1932x1916. 45° field of view. Retinal fundus photograph: 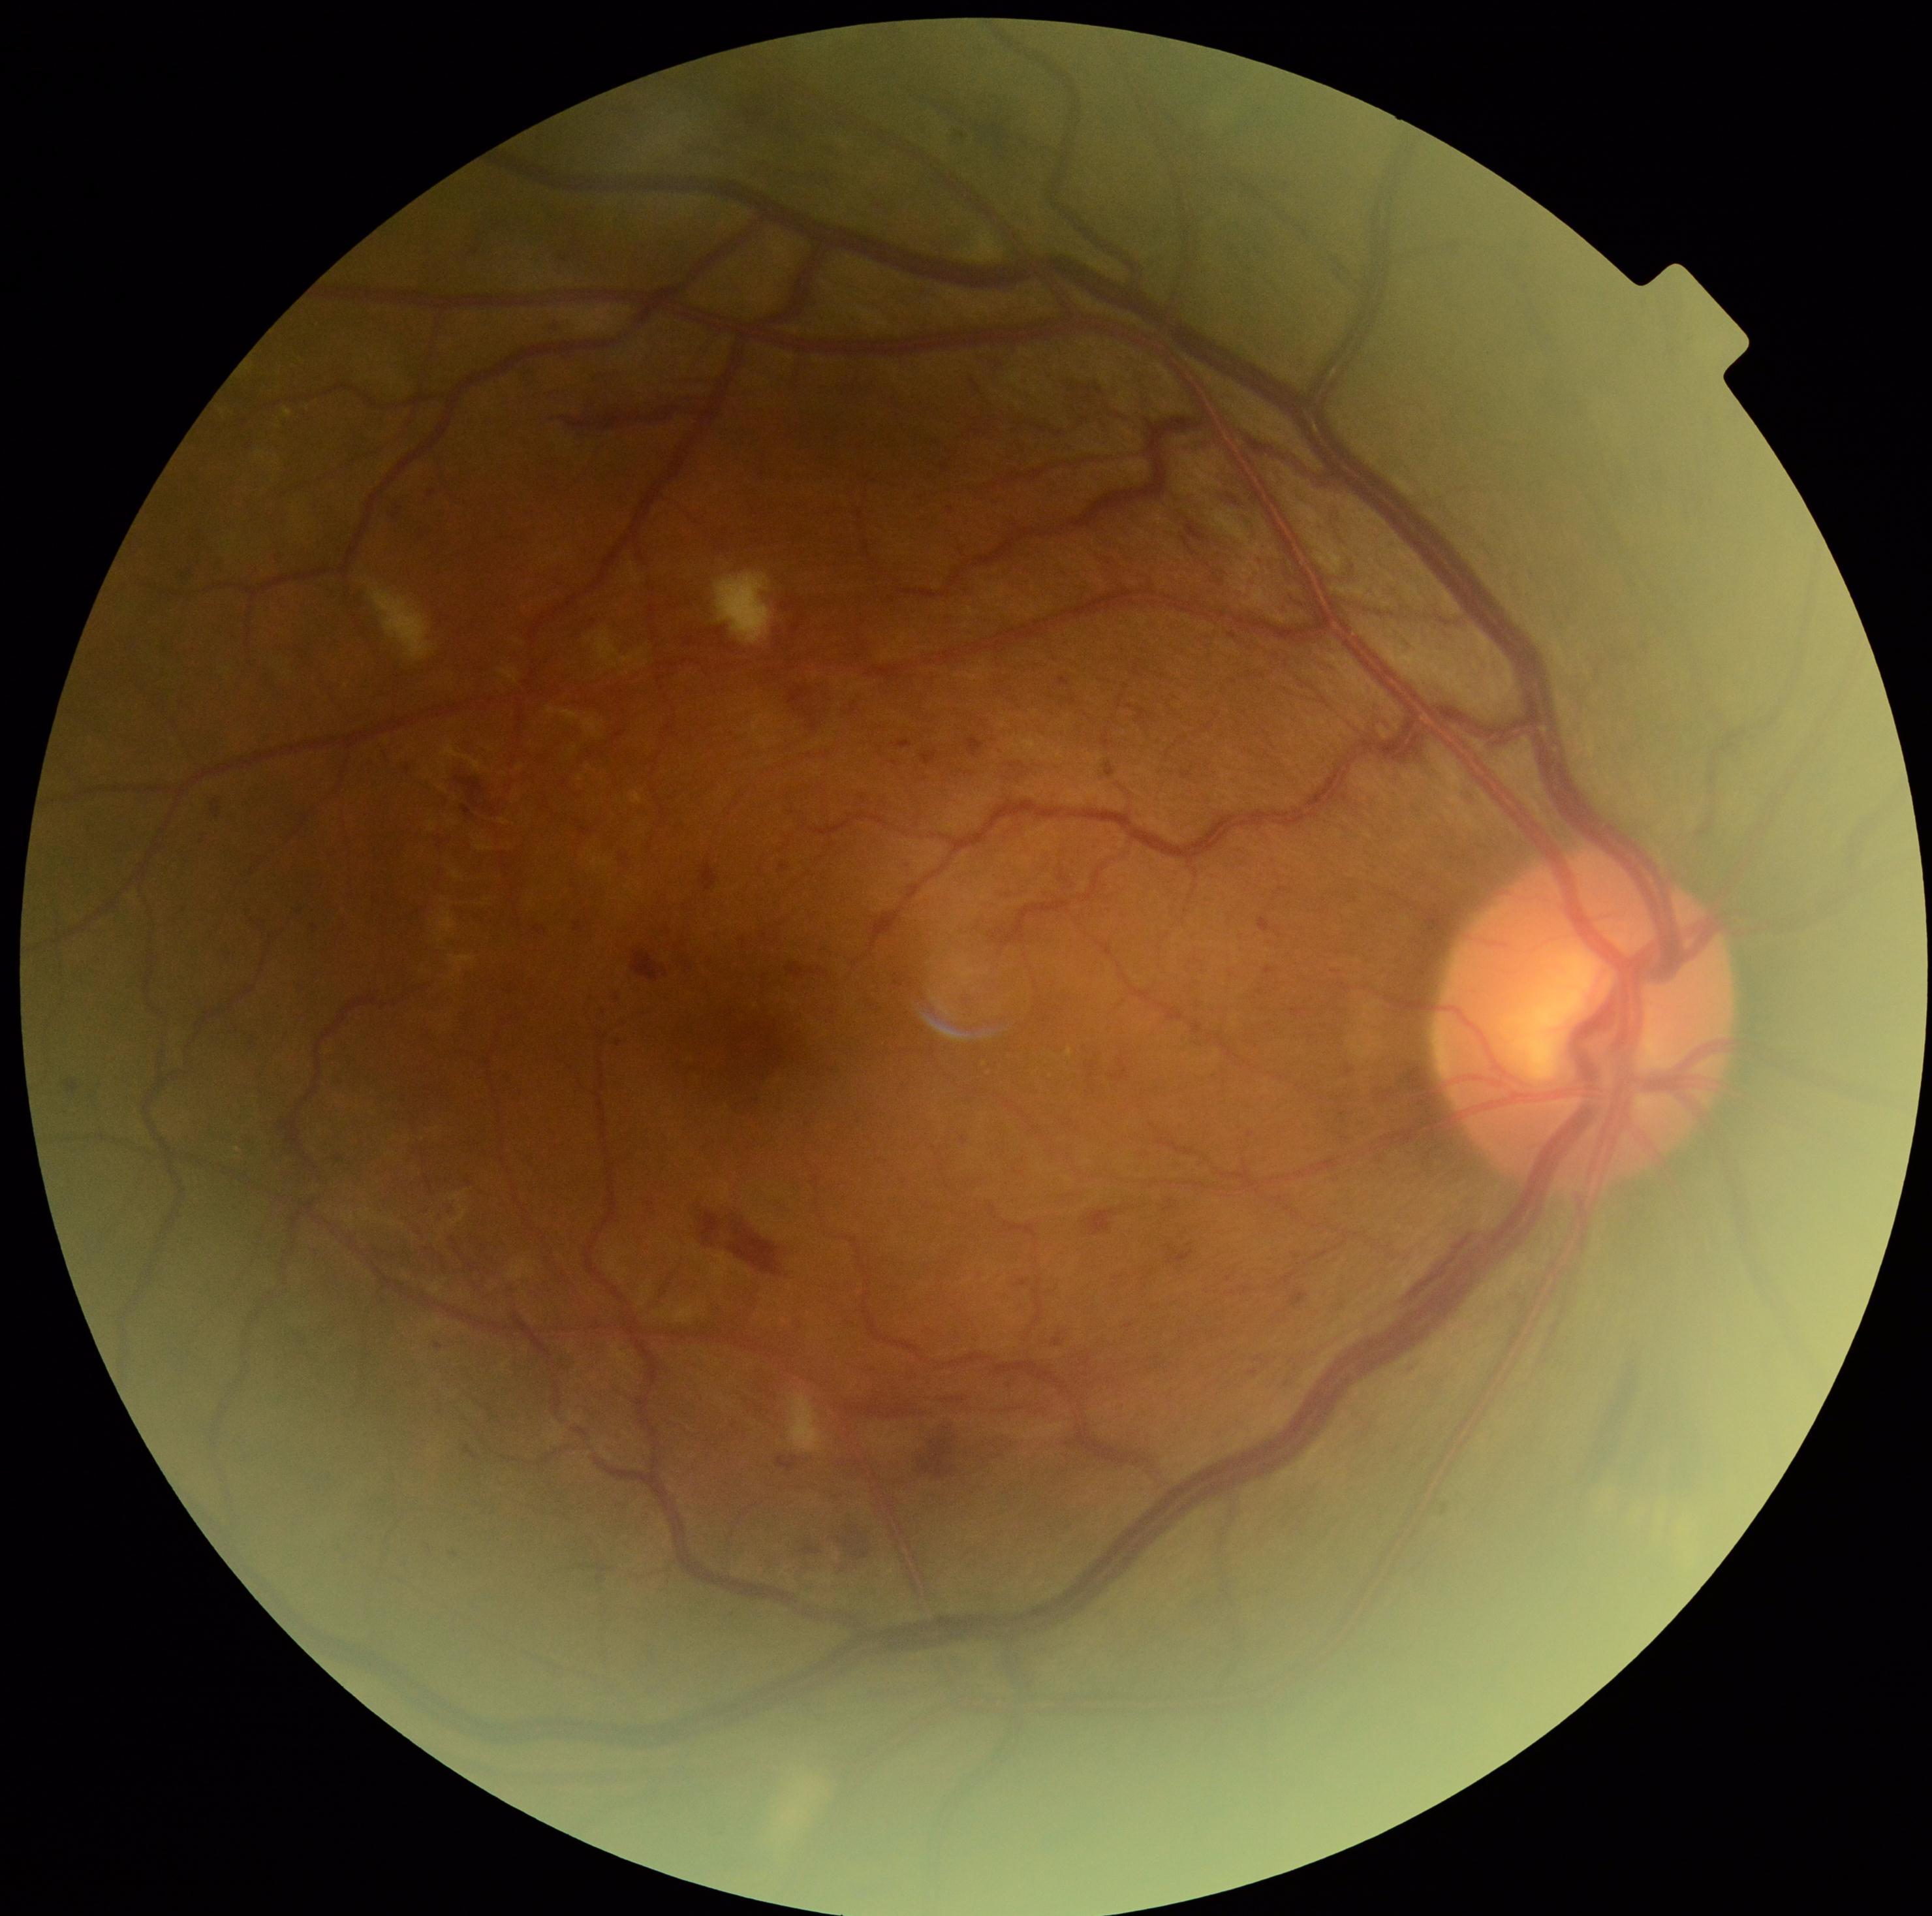

{
  "dr_grade": "3/4"
}